Captured with the Clarity RetCam 3 (130° field of view); infant wide-field fundus photograph
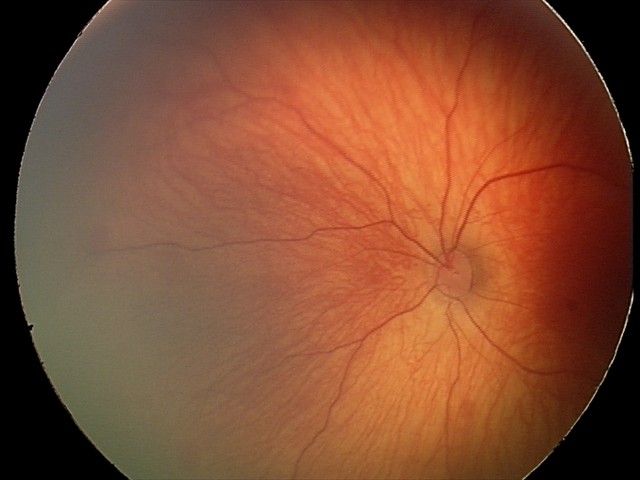
Assessment: retinal hemorrhages.